45-degree field of view.
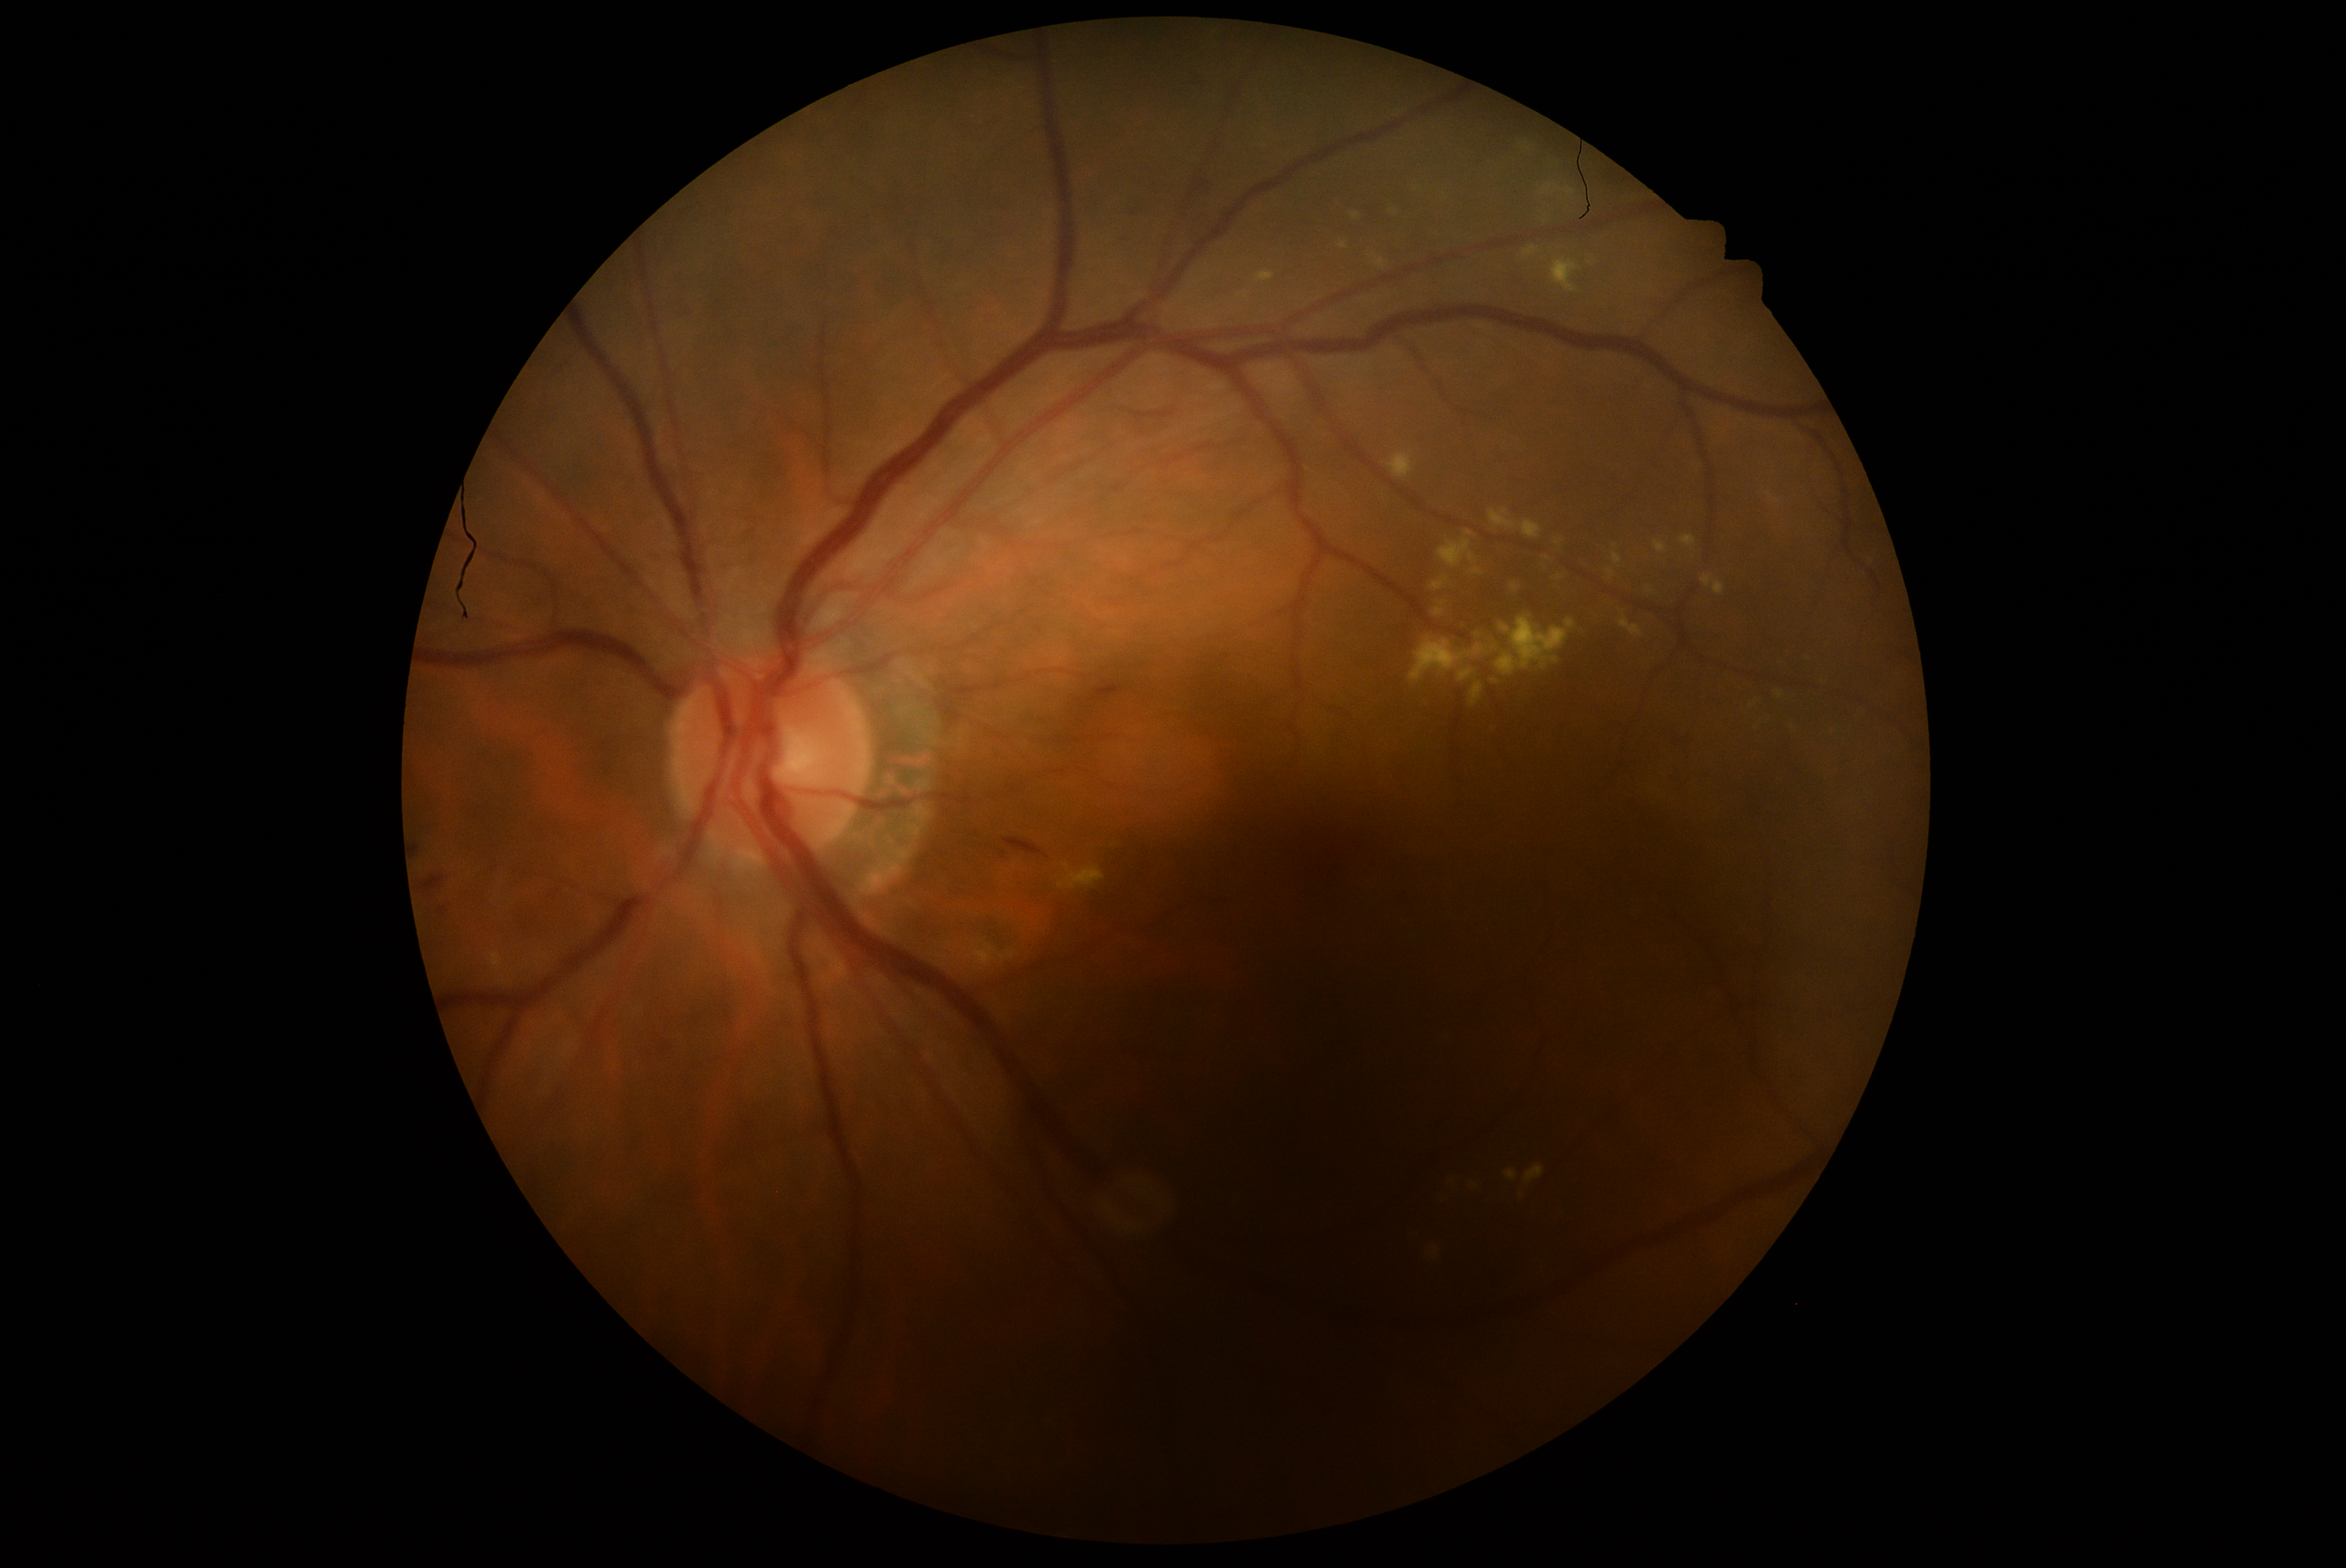   dr_grade: grade 2 (moderate NPDR)